35° FOV before cropping · disc-centered fundus crop.
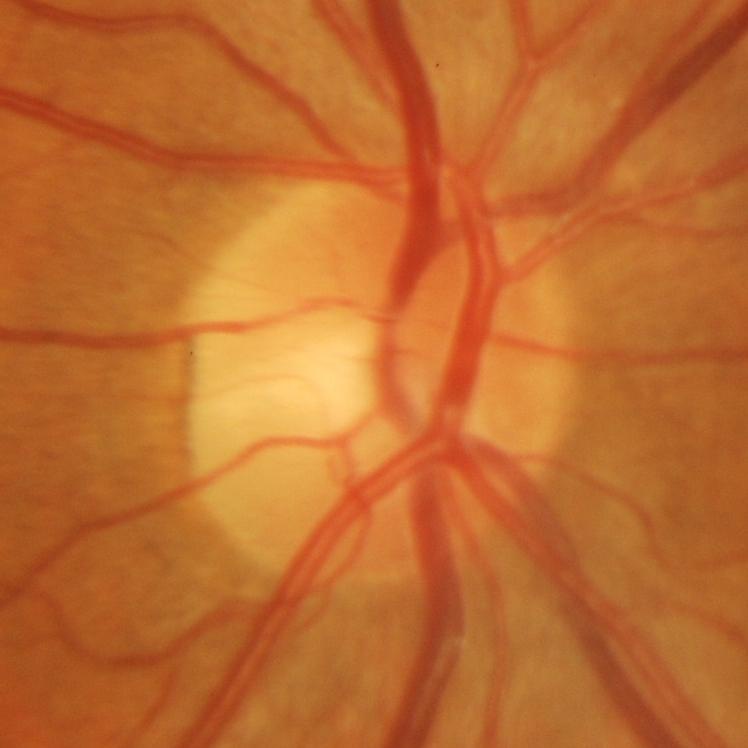
Consistent with glaucoma.